50° FOV, macula-centered, dilated-pupil acquisition: 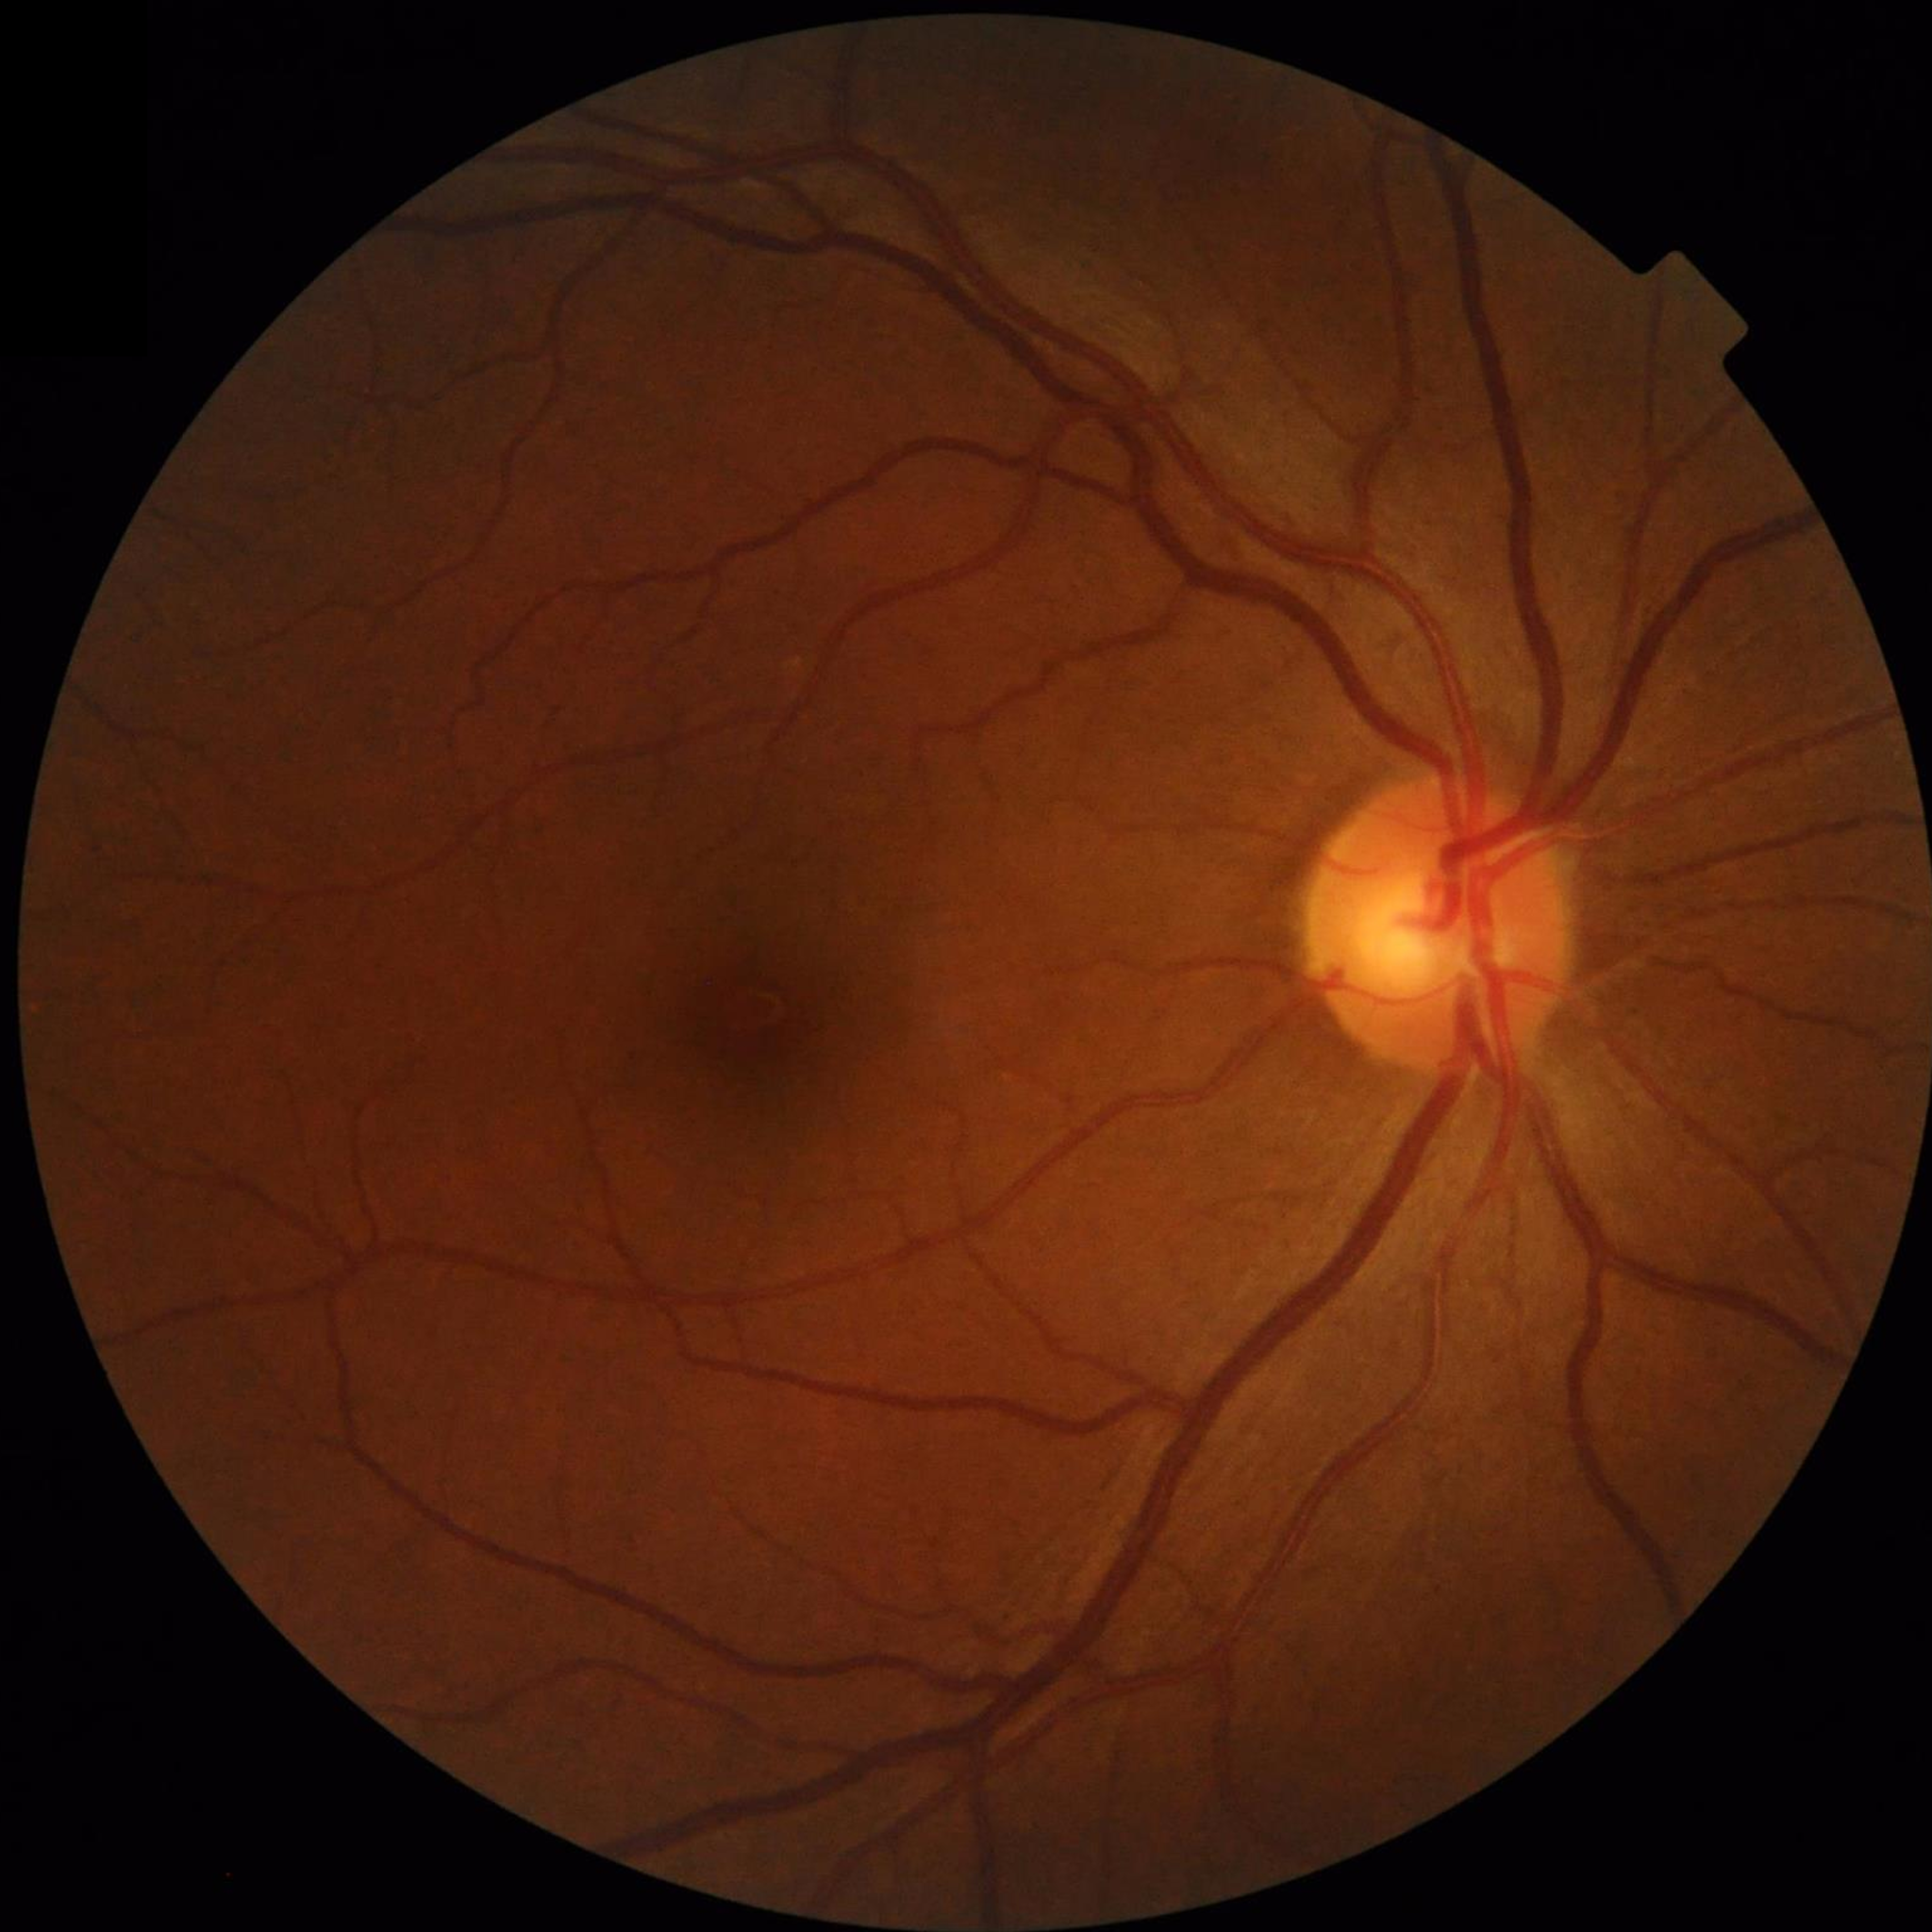

From a control without AMD, diabetic retinopathy, or glaucoma.